2048x1536: 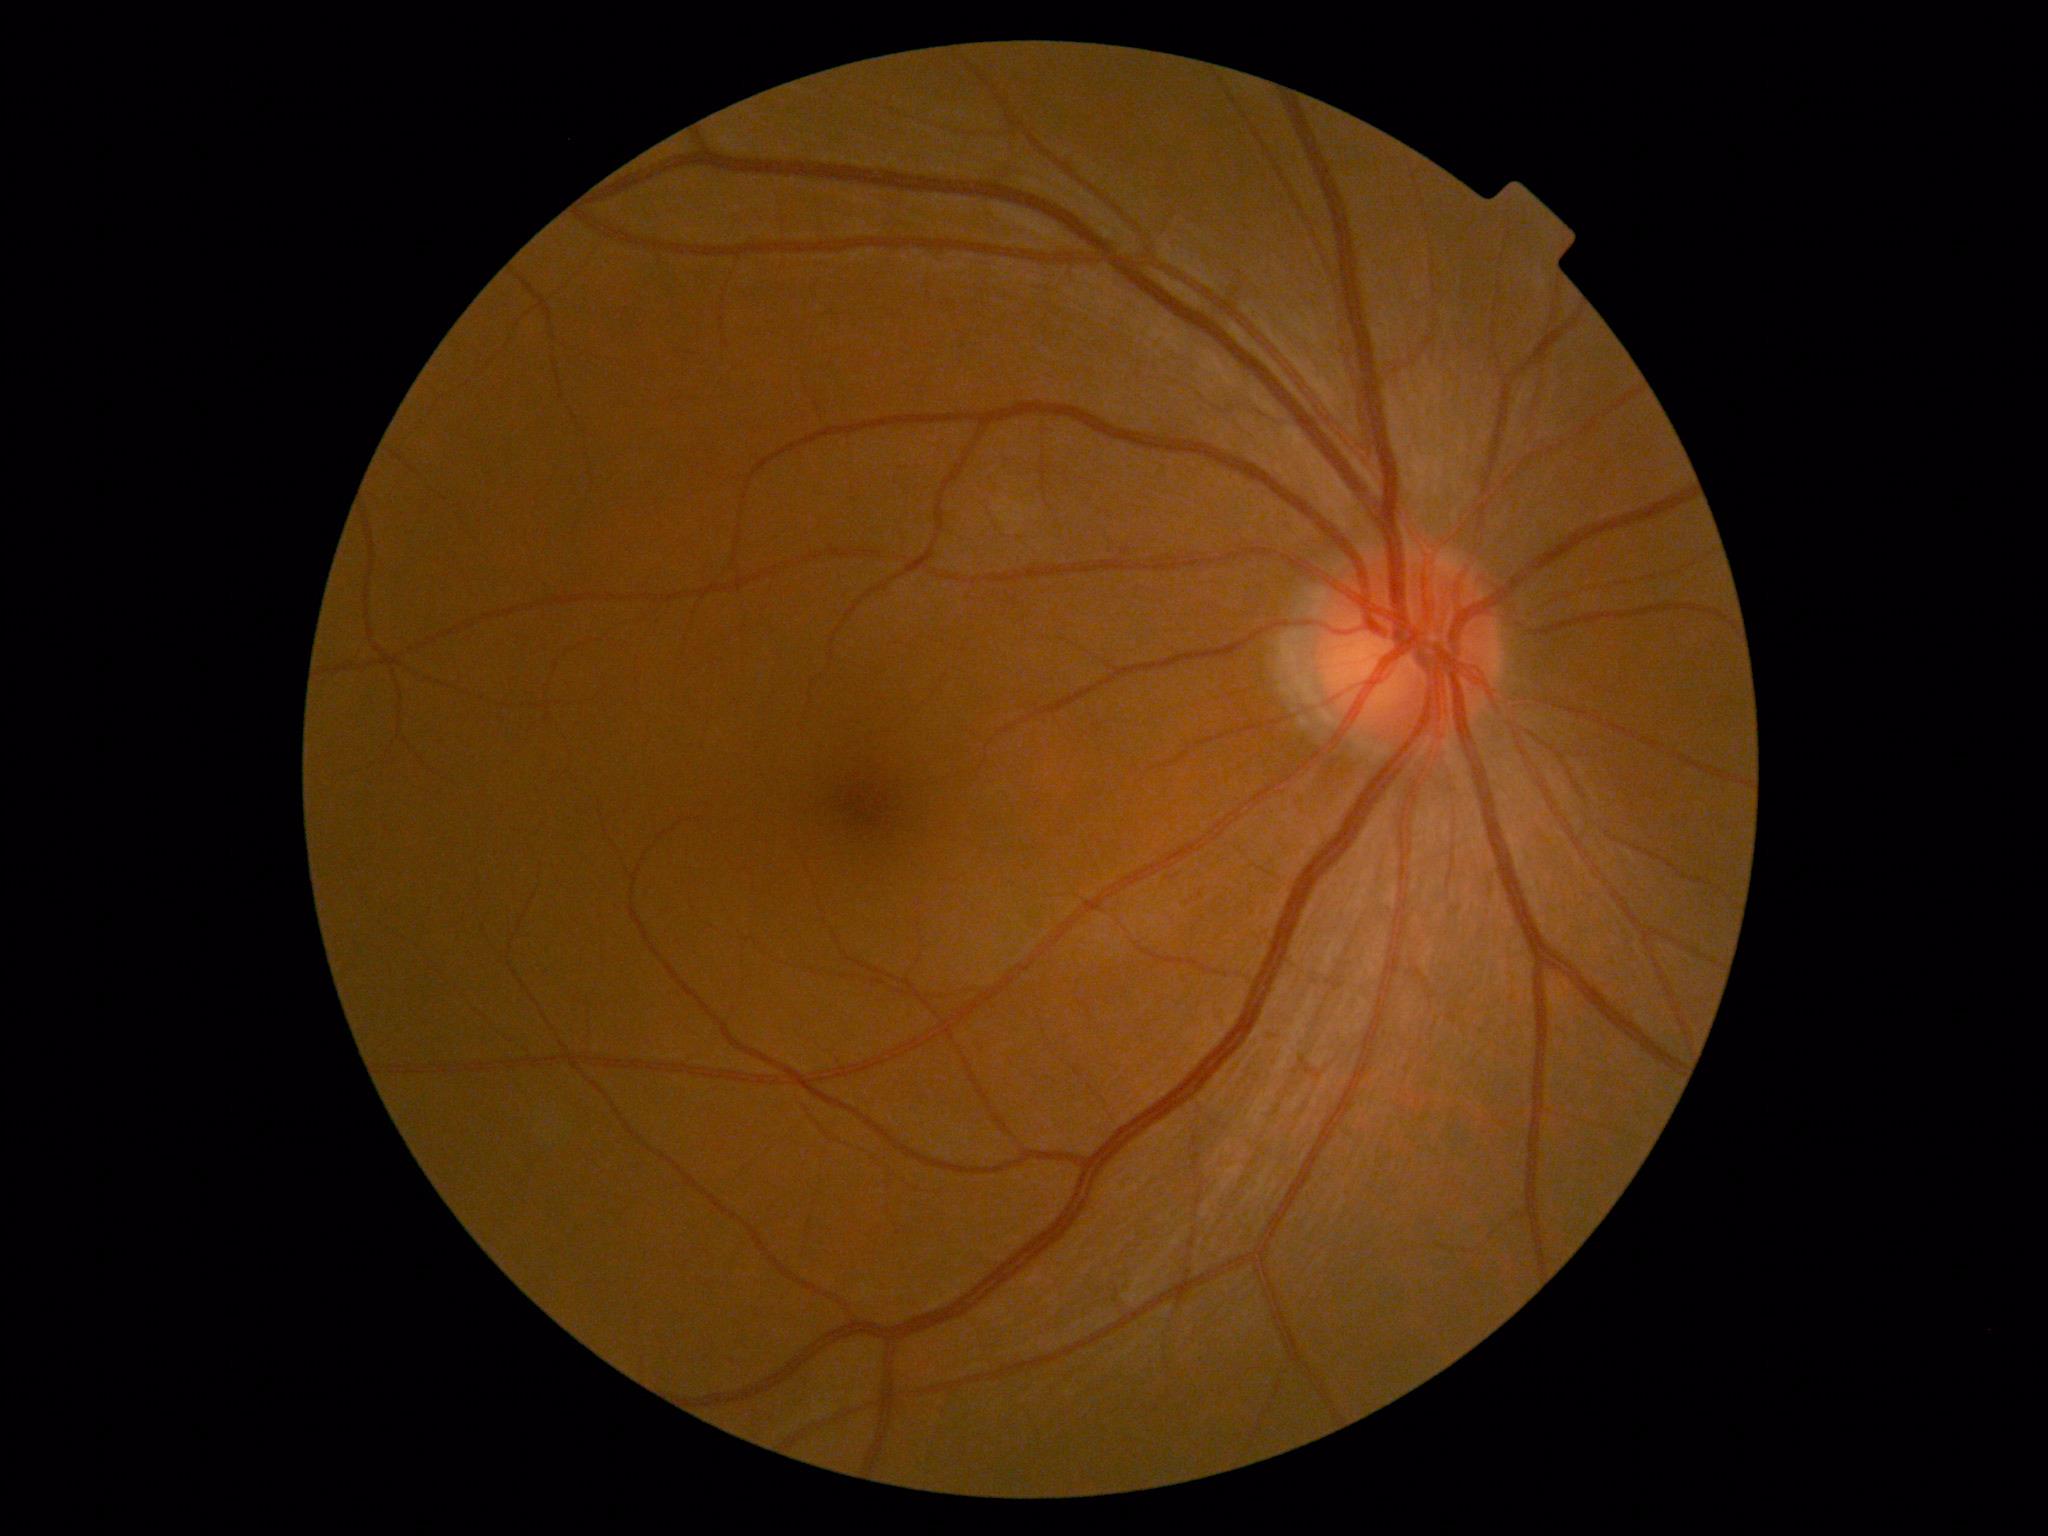 Diabetic retinopathy (DR) is no apparent retinopathy (grade 0).